Davis DR grading
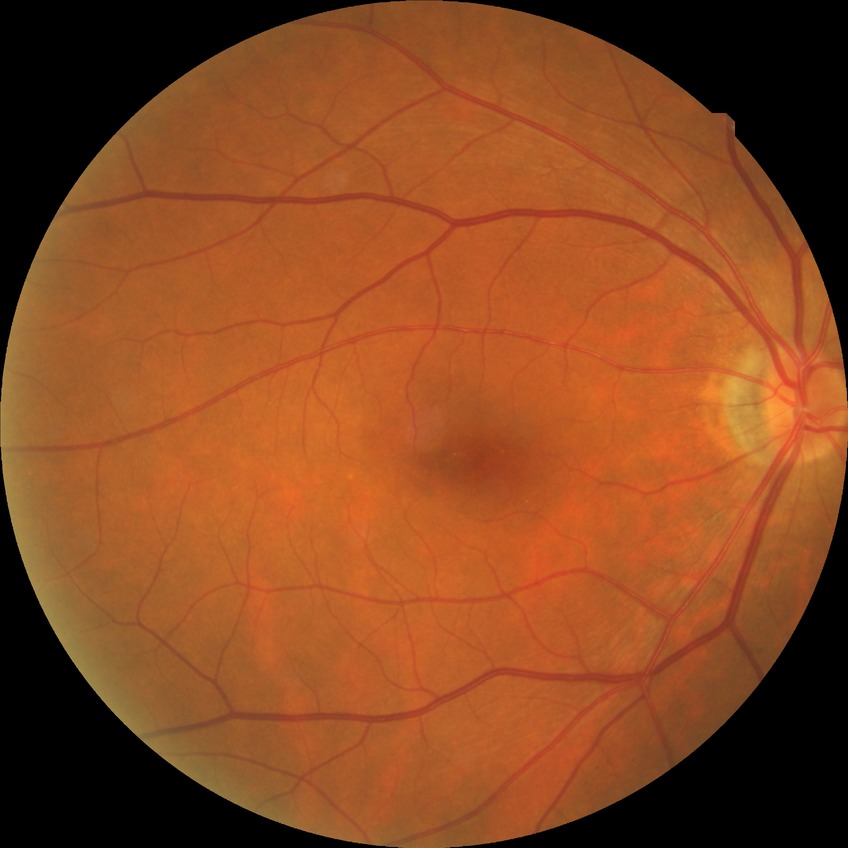 Diabetic retinopathy (DR) is SDR (simple diabetic retinopathy).